NIDEK AFC-230. Graded on the modified Davis scale — 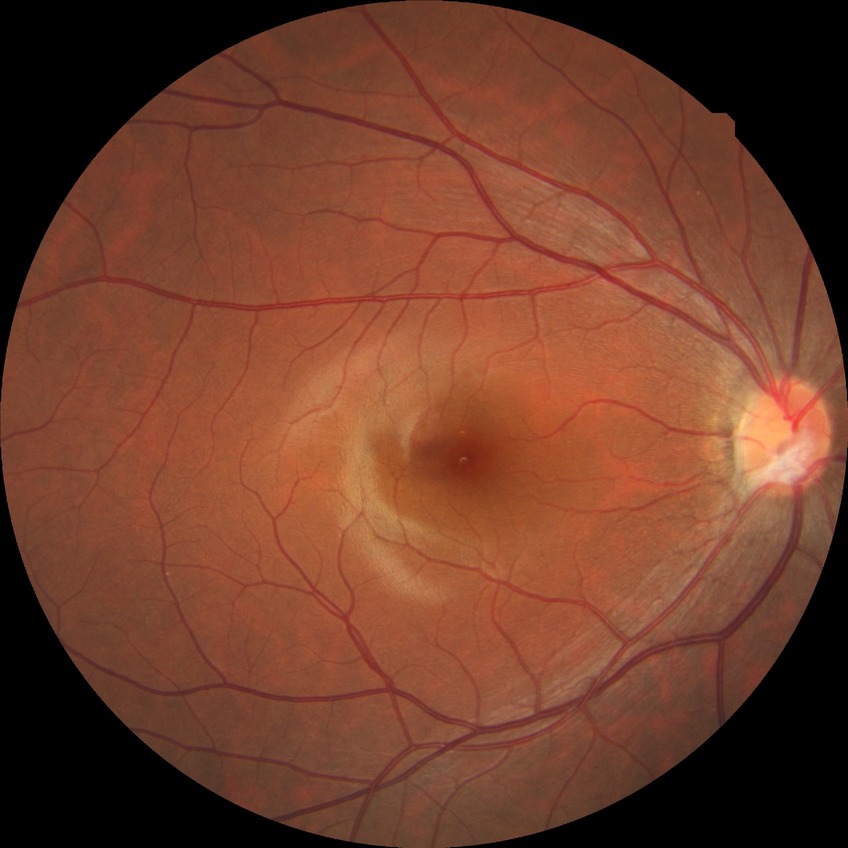

DR severity: NDR. No diabetic retinal disease findings.